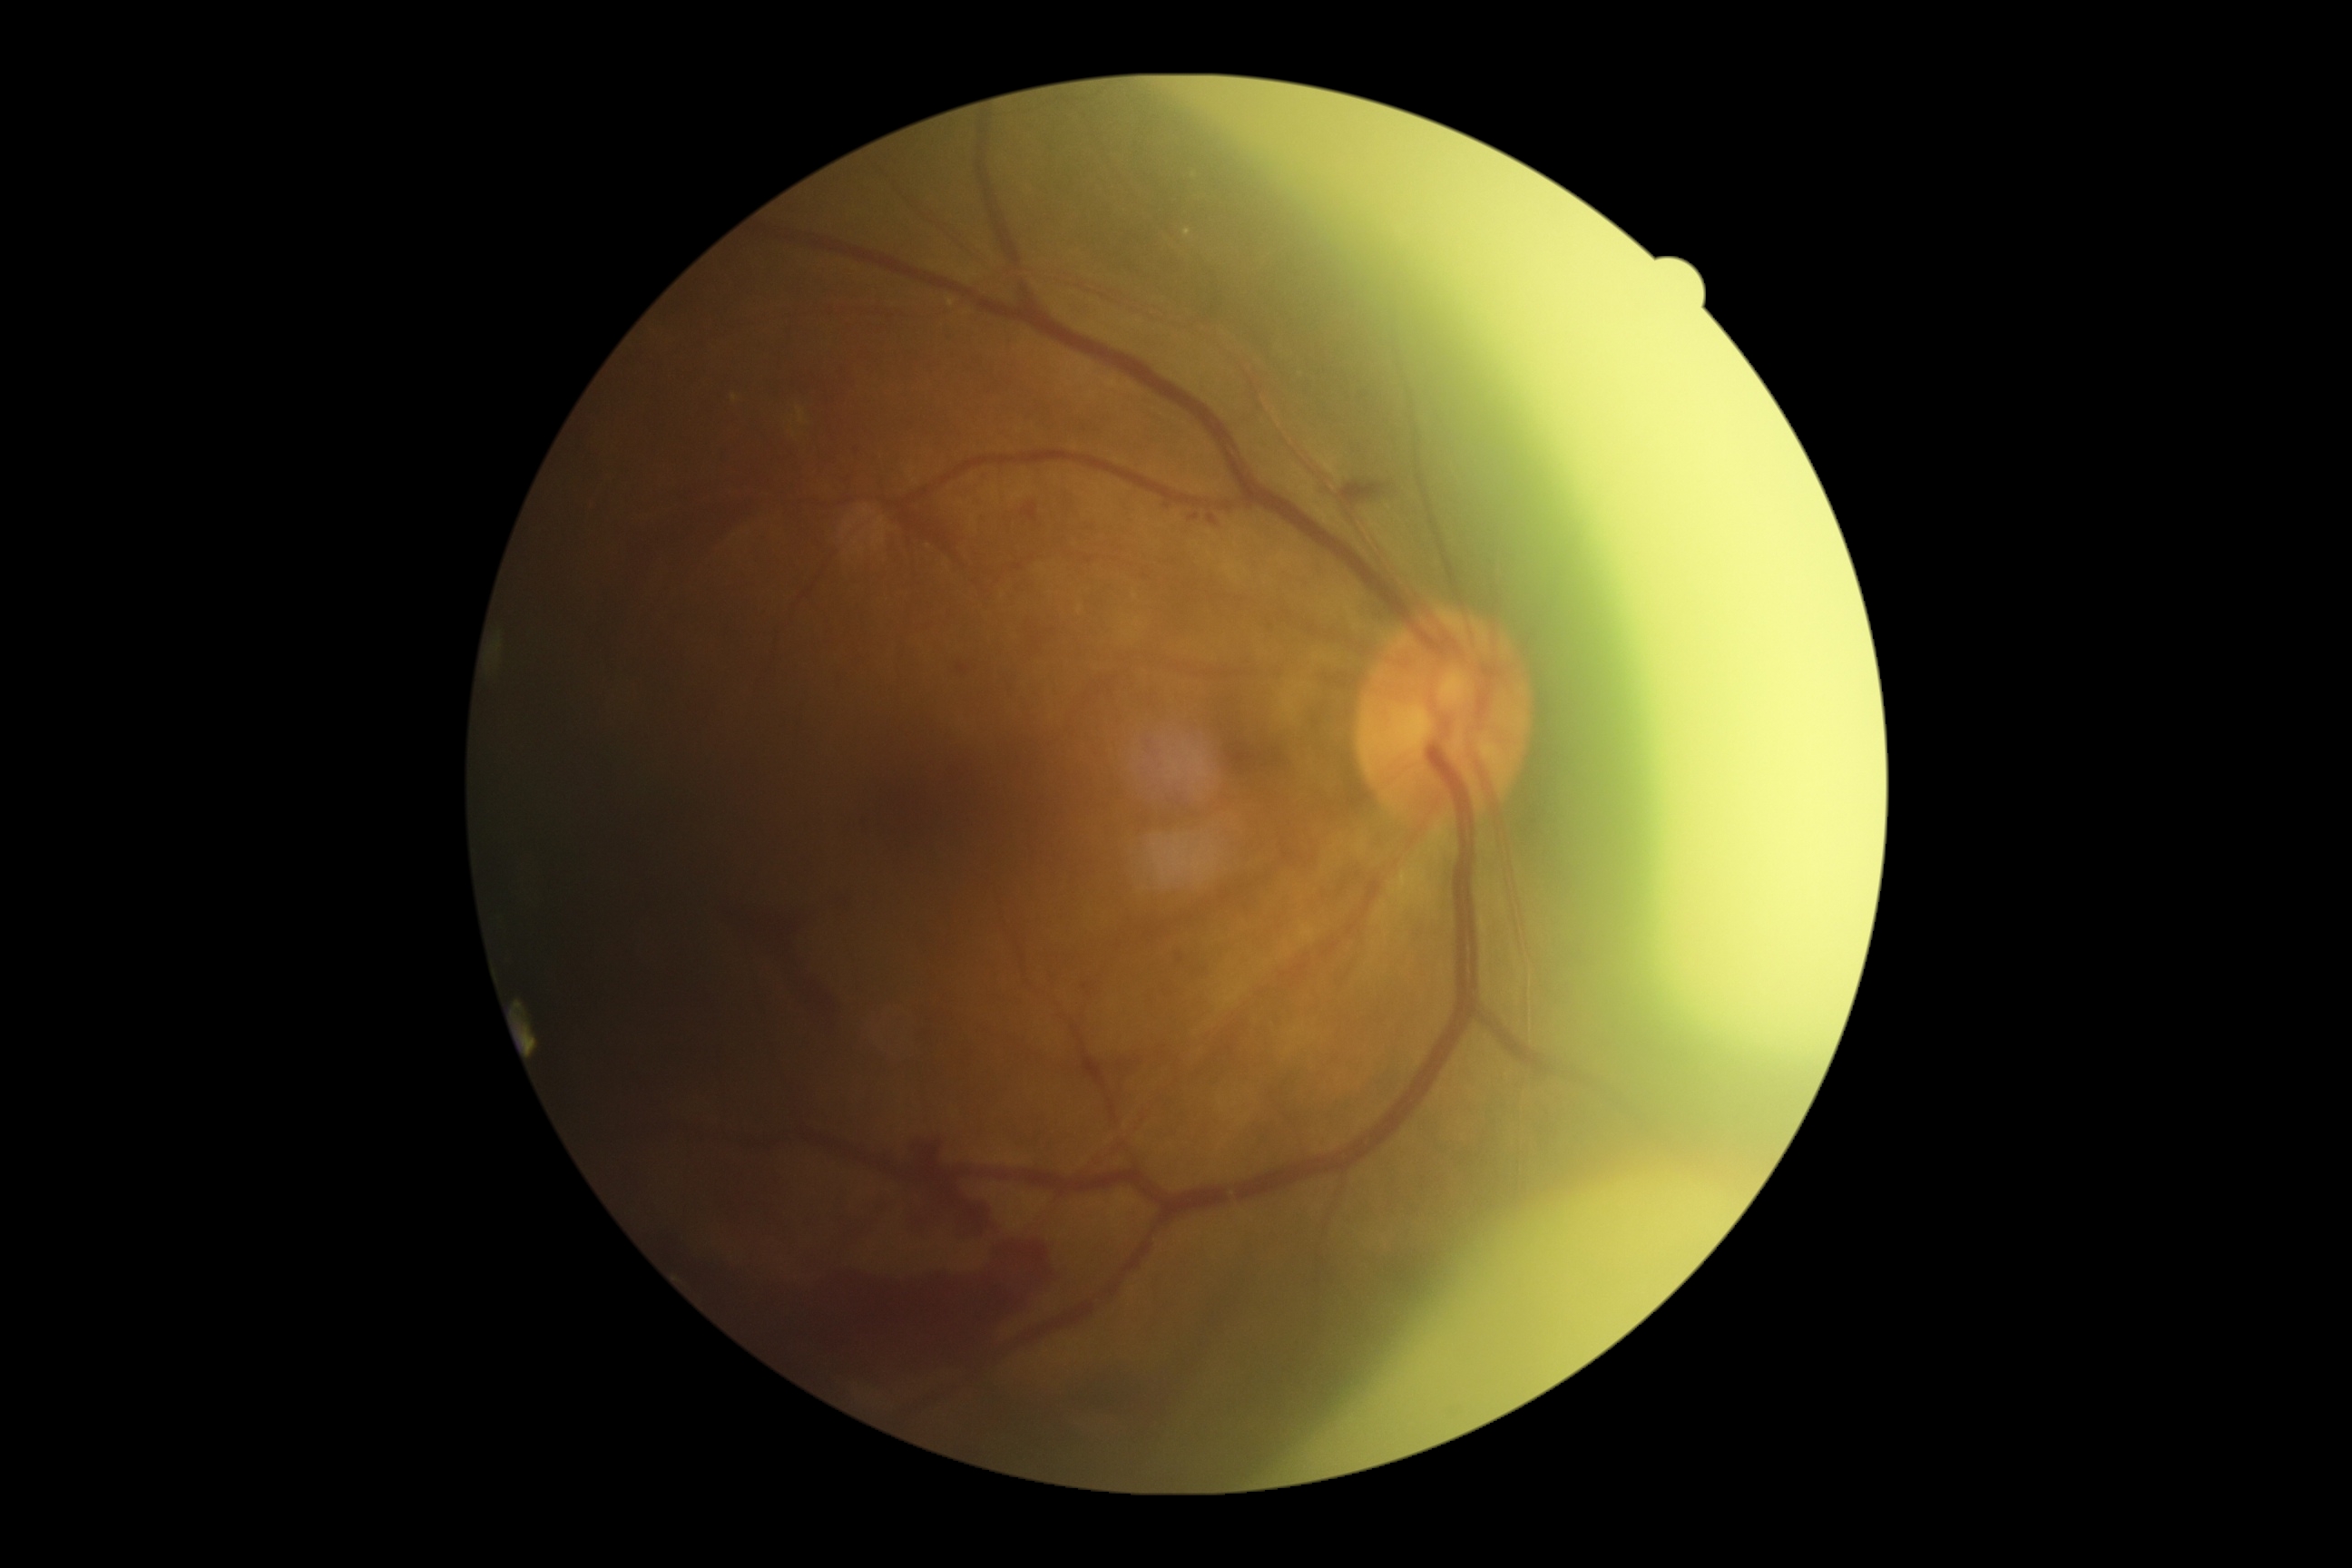 dr_category: proliferative diabetic retinopathy
dr_grade: 4 — neovascularization and/or vitreous/pre-retinal hemorrhage